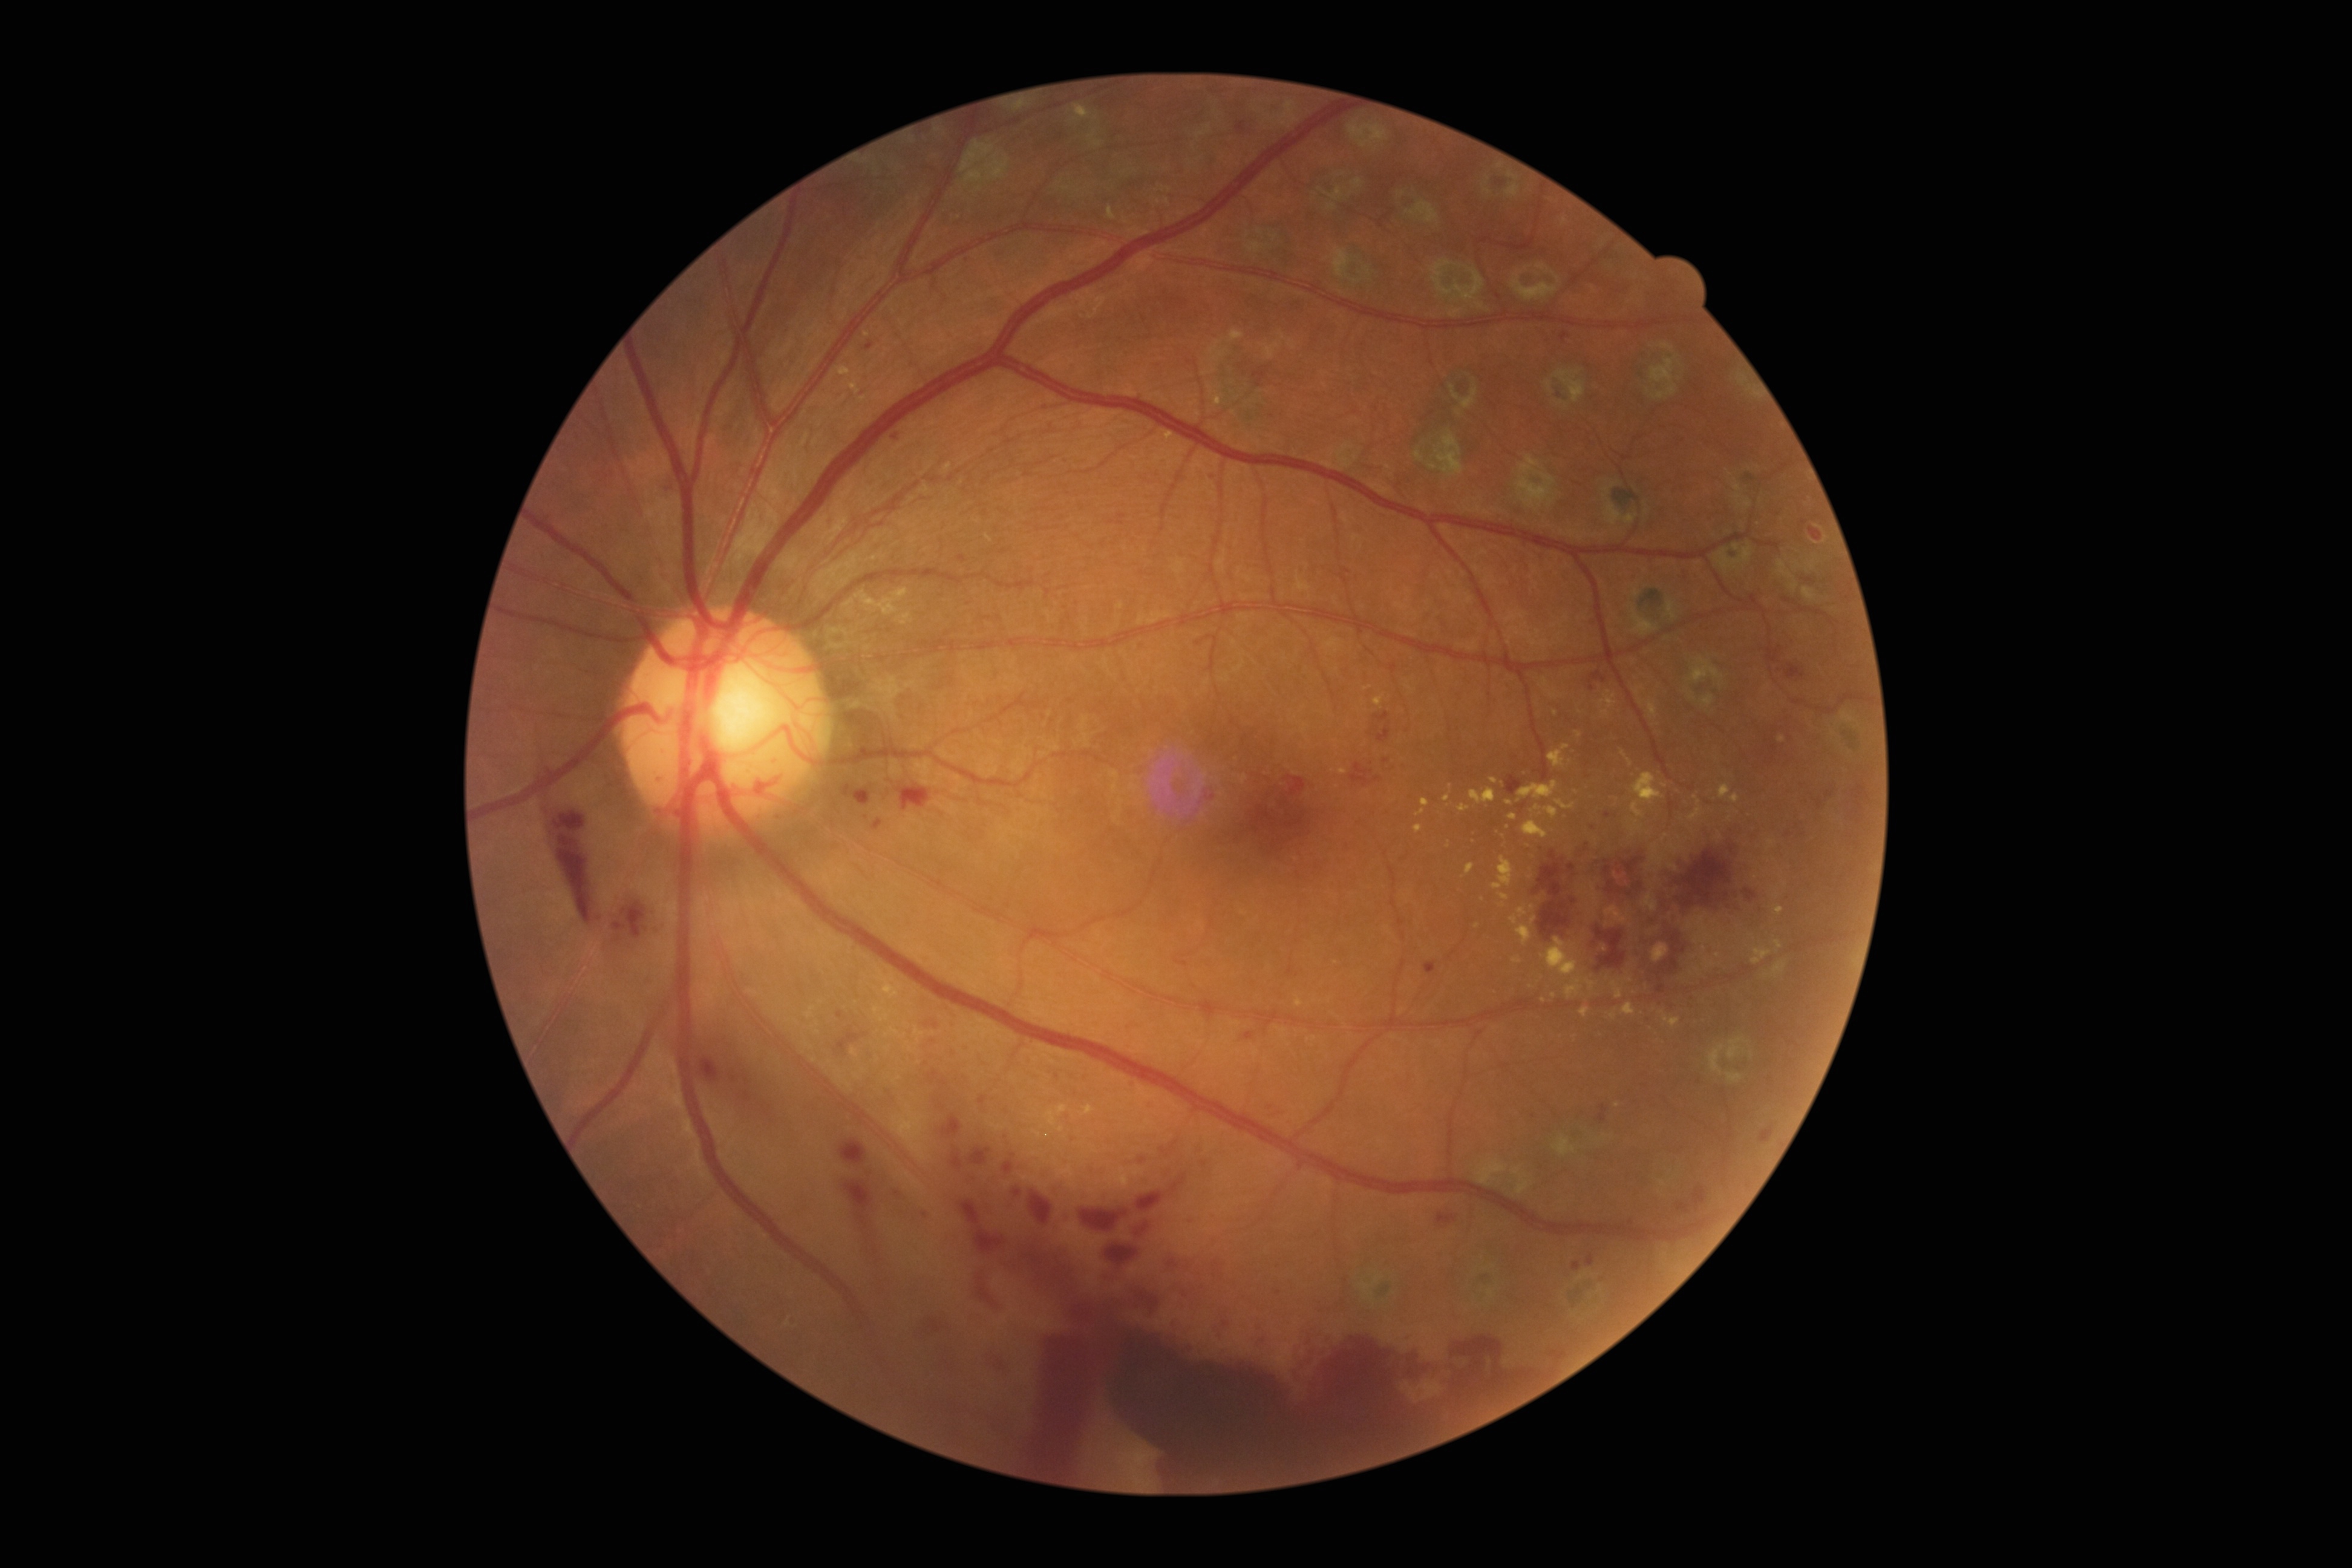

DR severity is PDR (grade 4).